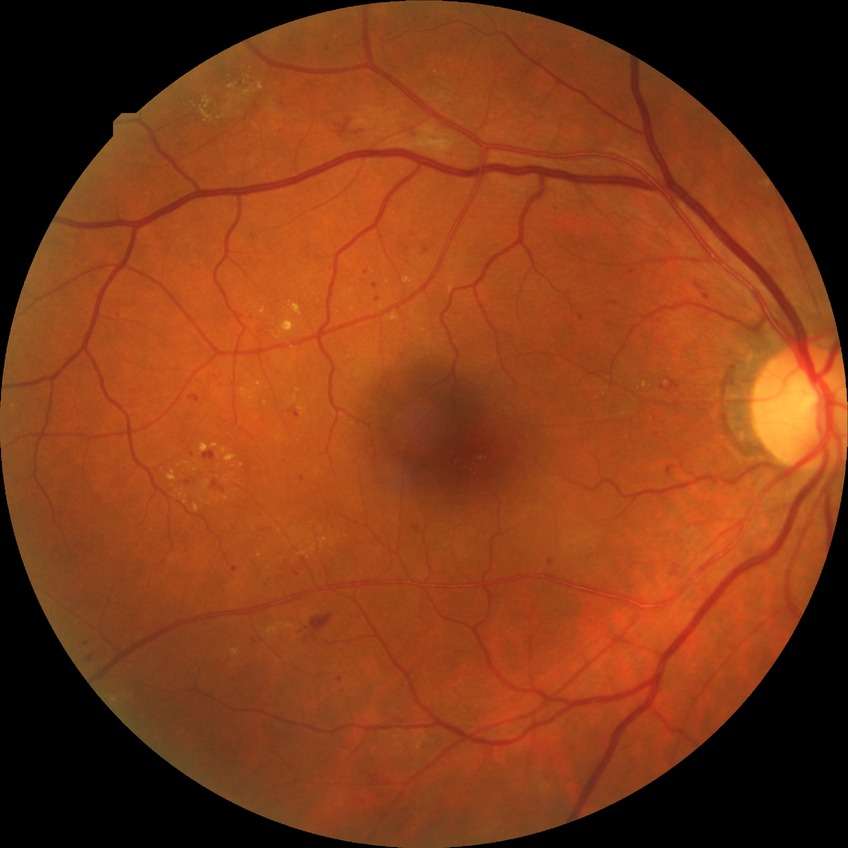
diabetic retinopathy severity=pre-proliferative diabetic retinopathy.